1659 x 2212 pixels, captured on a Remidio FOP fundus camera: 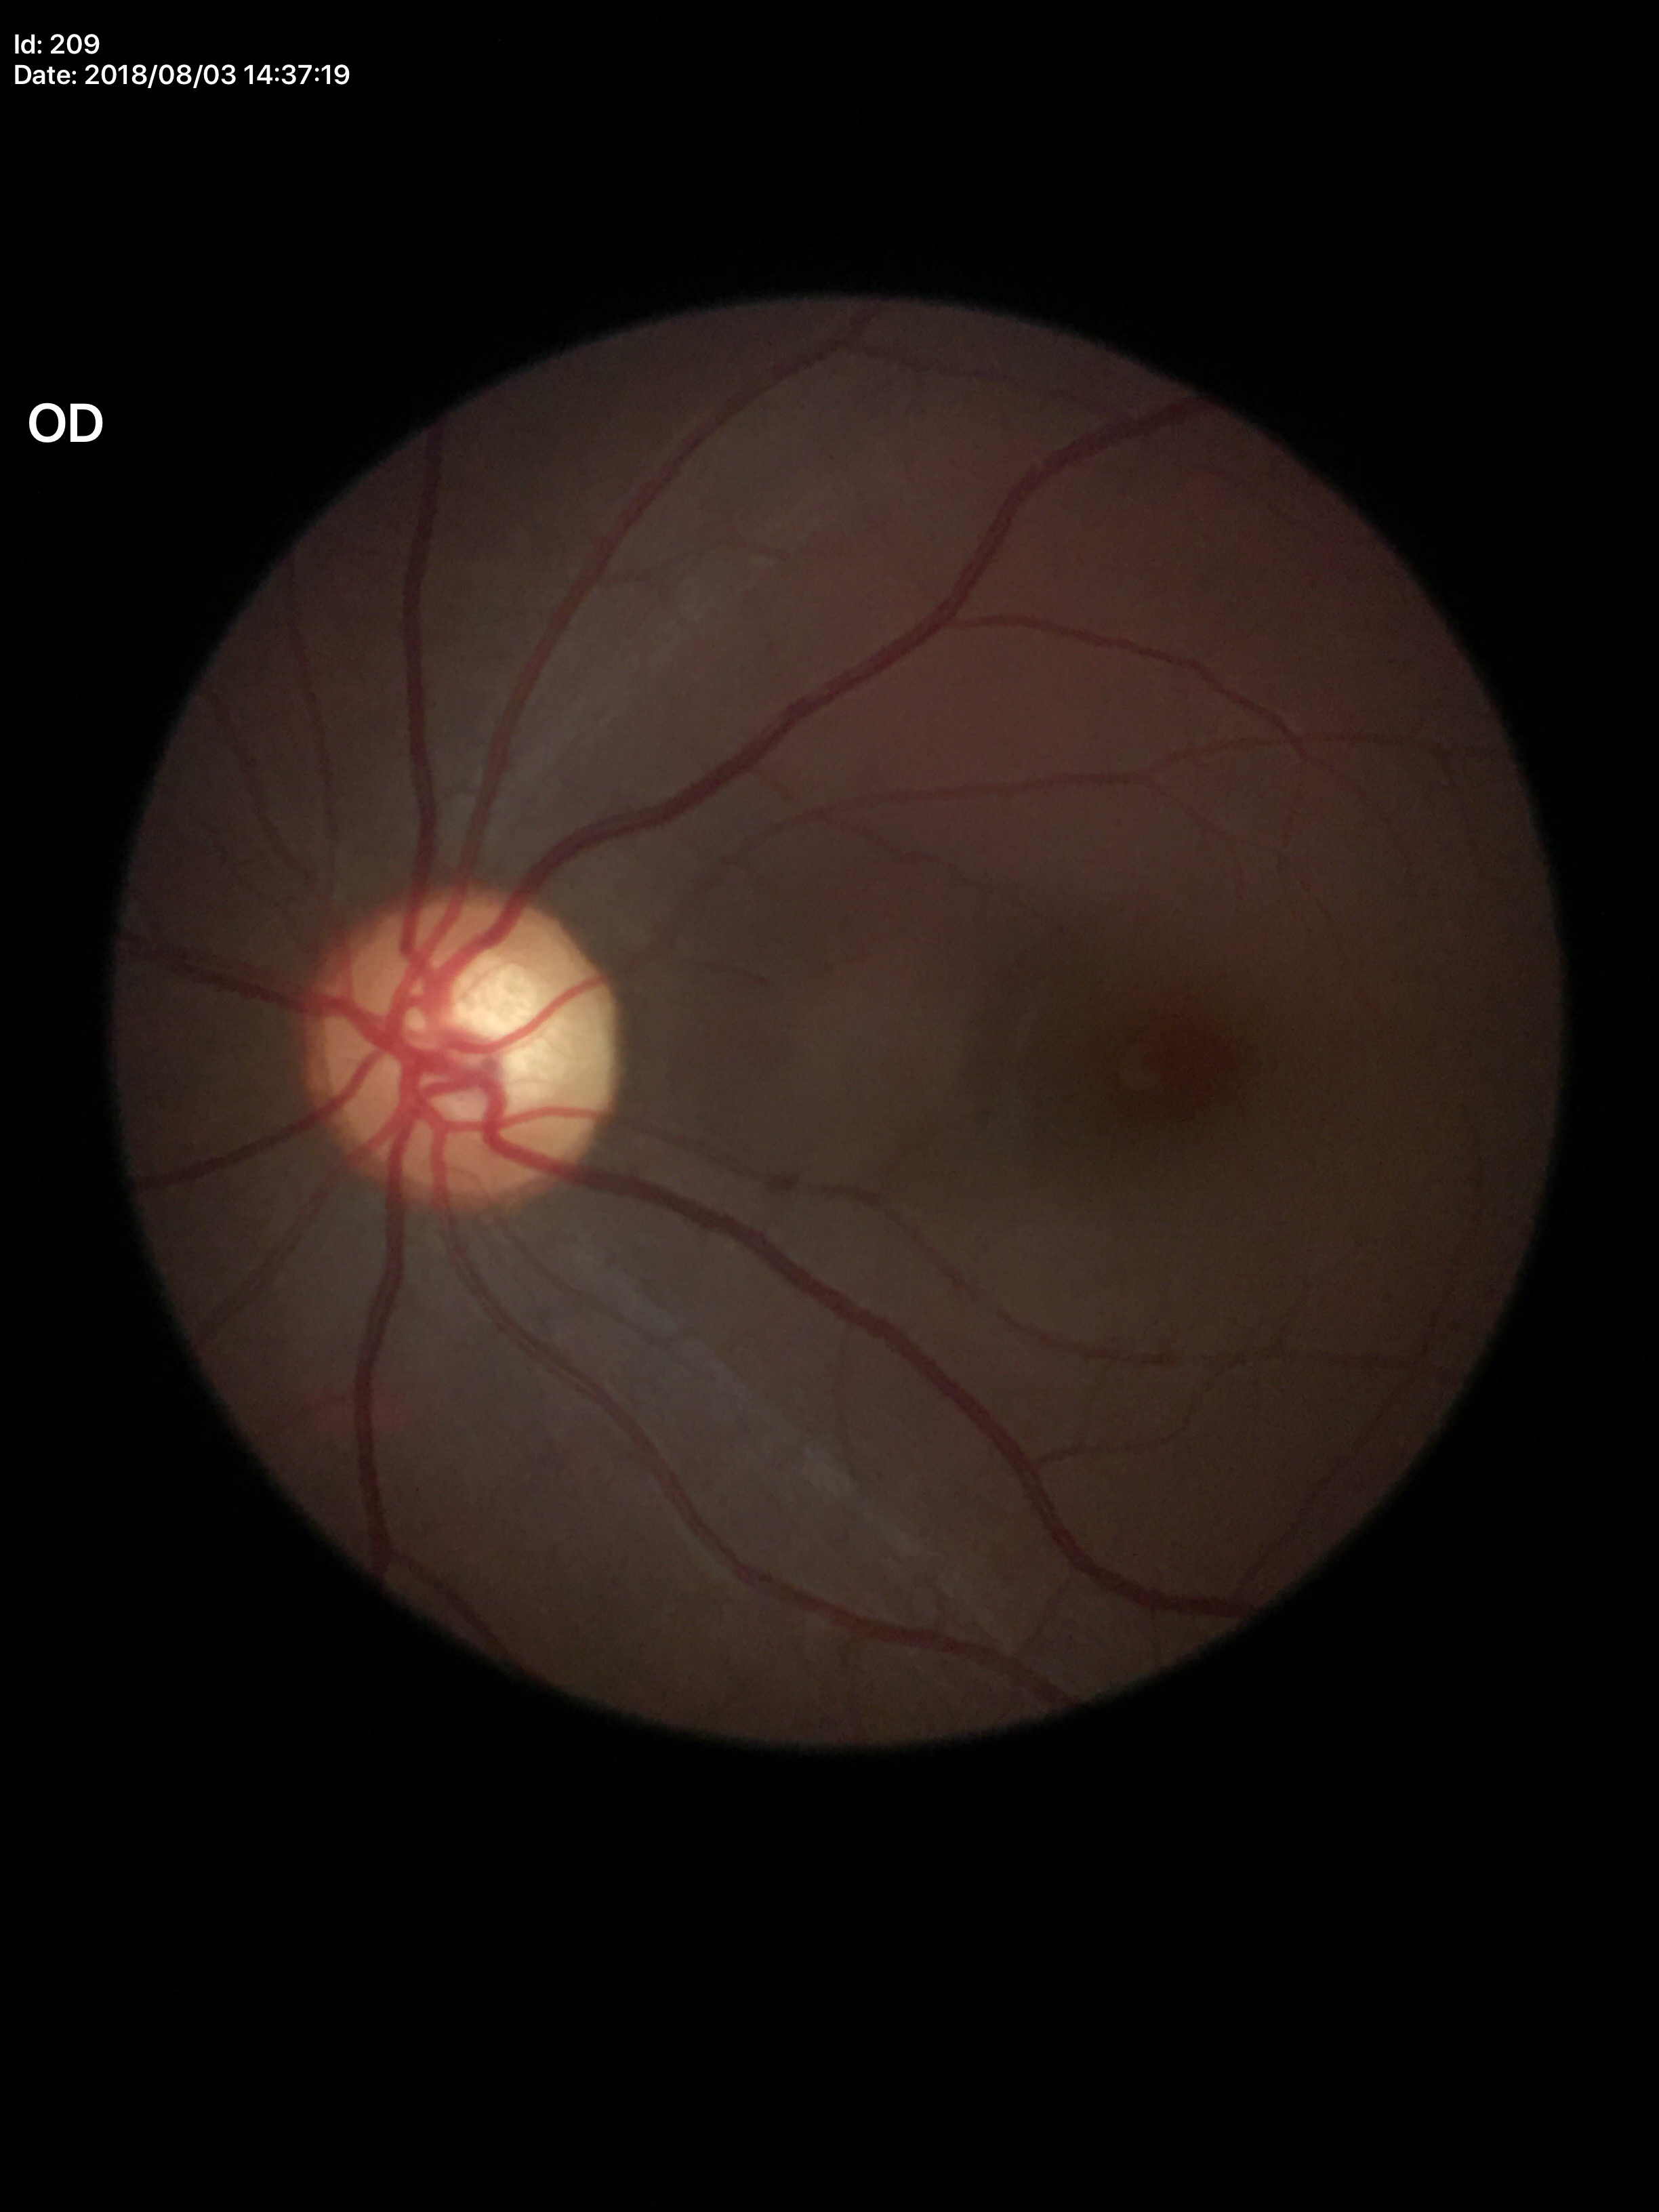

Glaucoma assessment: suspicious
vertical cup-to-disc ratio: 0.60